Camera: NIDEK AFC-230, nonmydriatic fundus photograph, 45-degree field of view
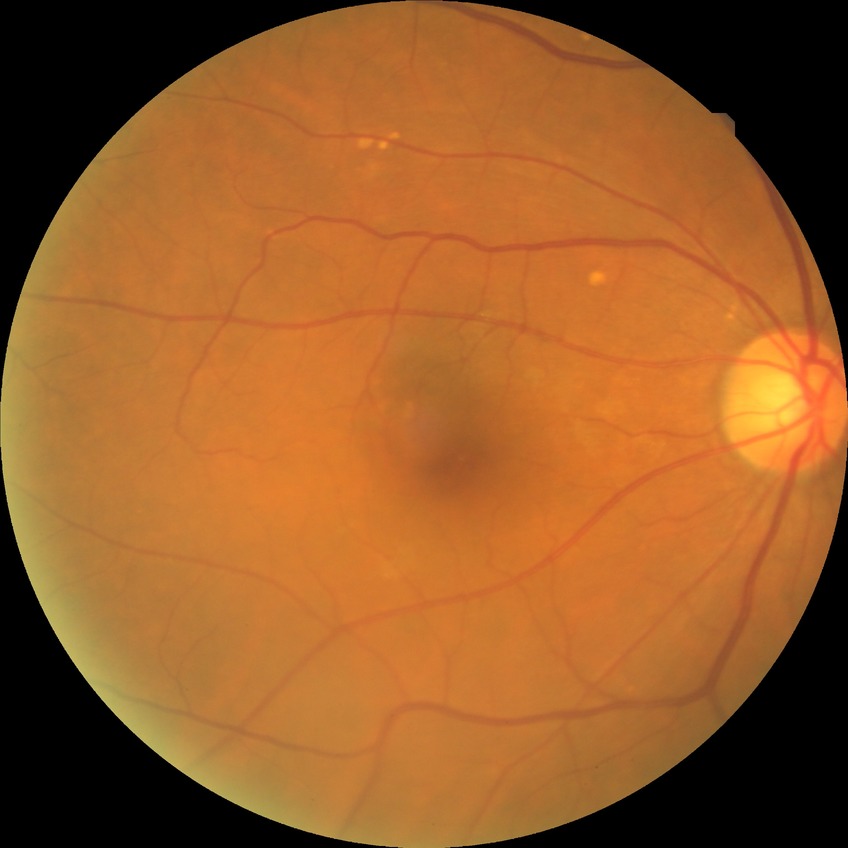
Diabetic retinopathy (DR) is NDR (no diabetic retinopathy).